Captured on a Remidio FOP fundus camera.
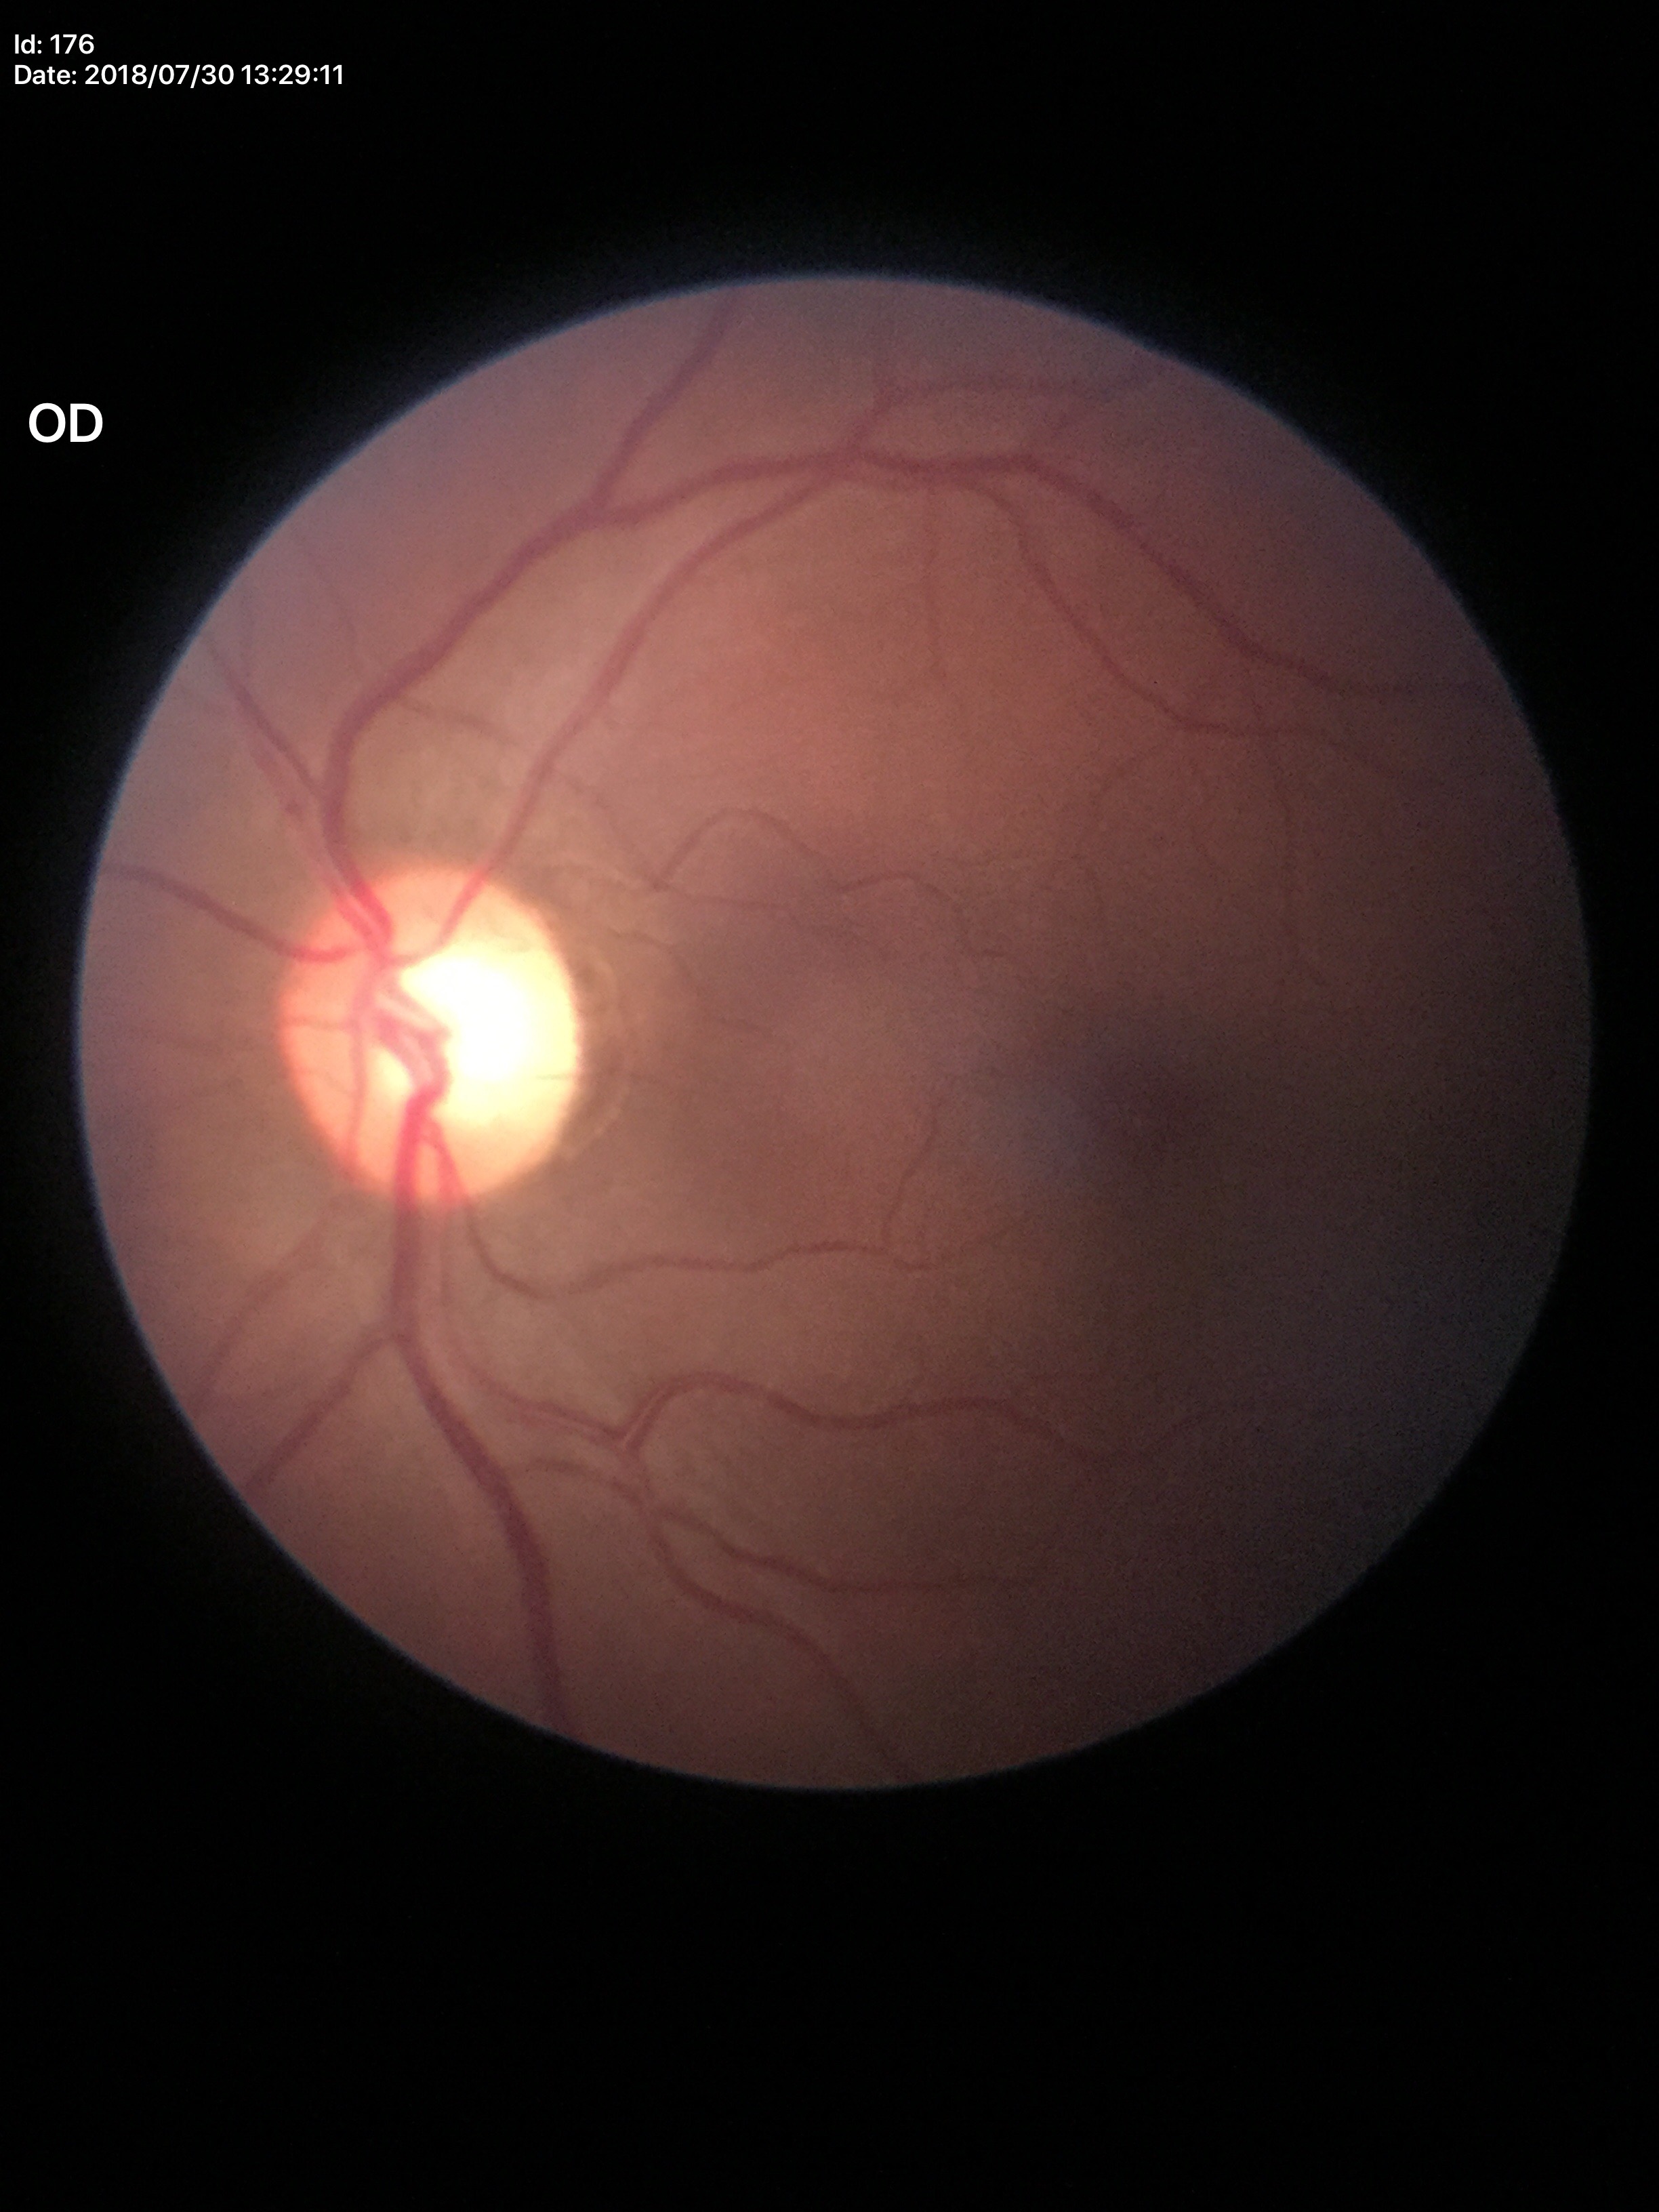 Glaucoma screening: no suspicious findings (2 of 5 graders flagged glaucoma suspect). Vertical C/D ratio (VCDR): 0.65.